Acquired with a NIDEK AFC-230, no pharmacologic dilation, modified Davis classification — 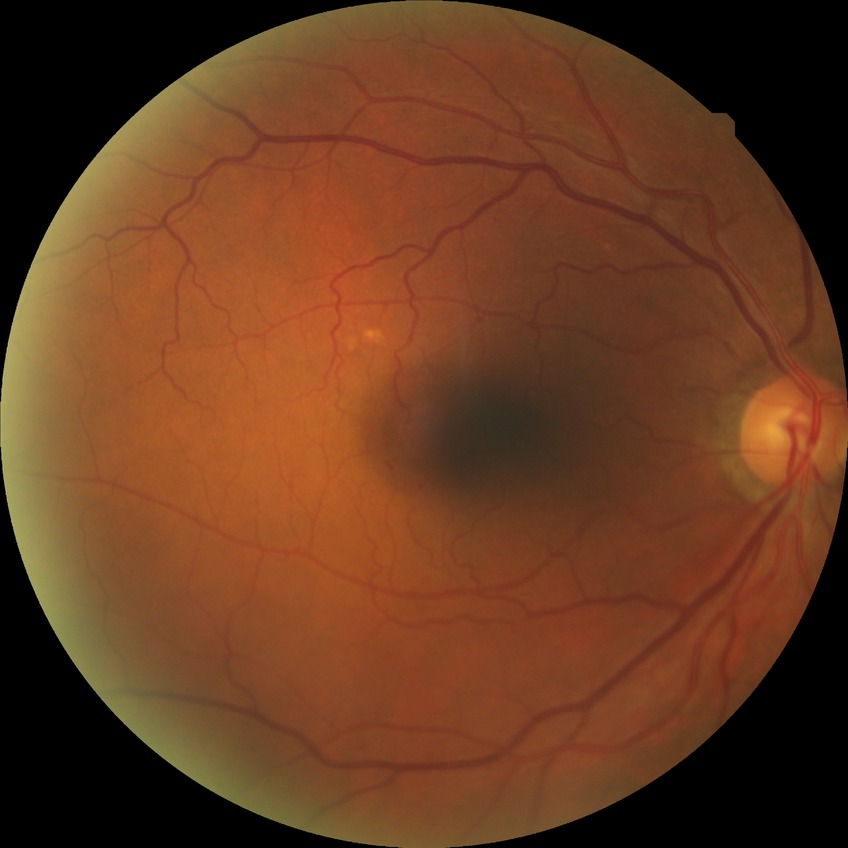 Retinopathy stage is no diabetic retinopathy.